45-degree field of view.
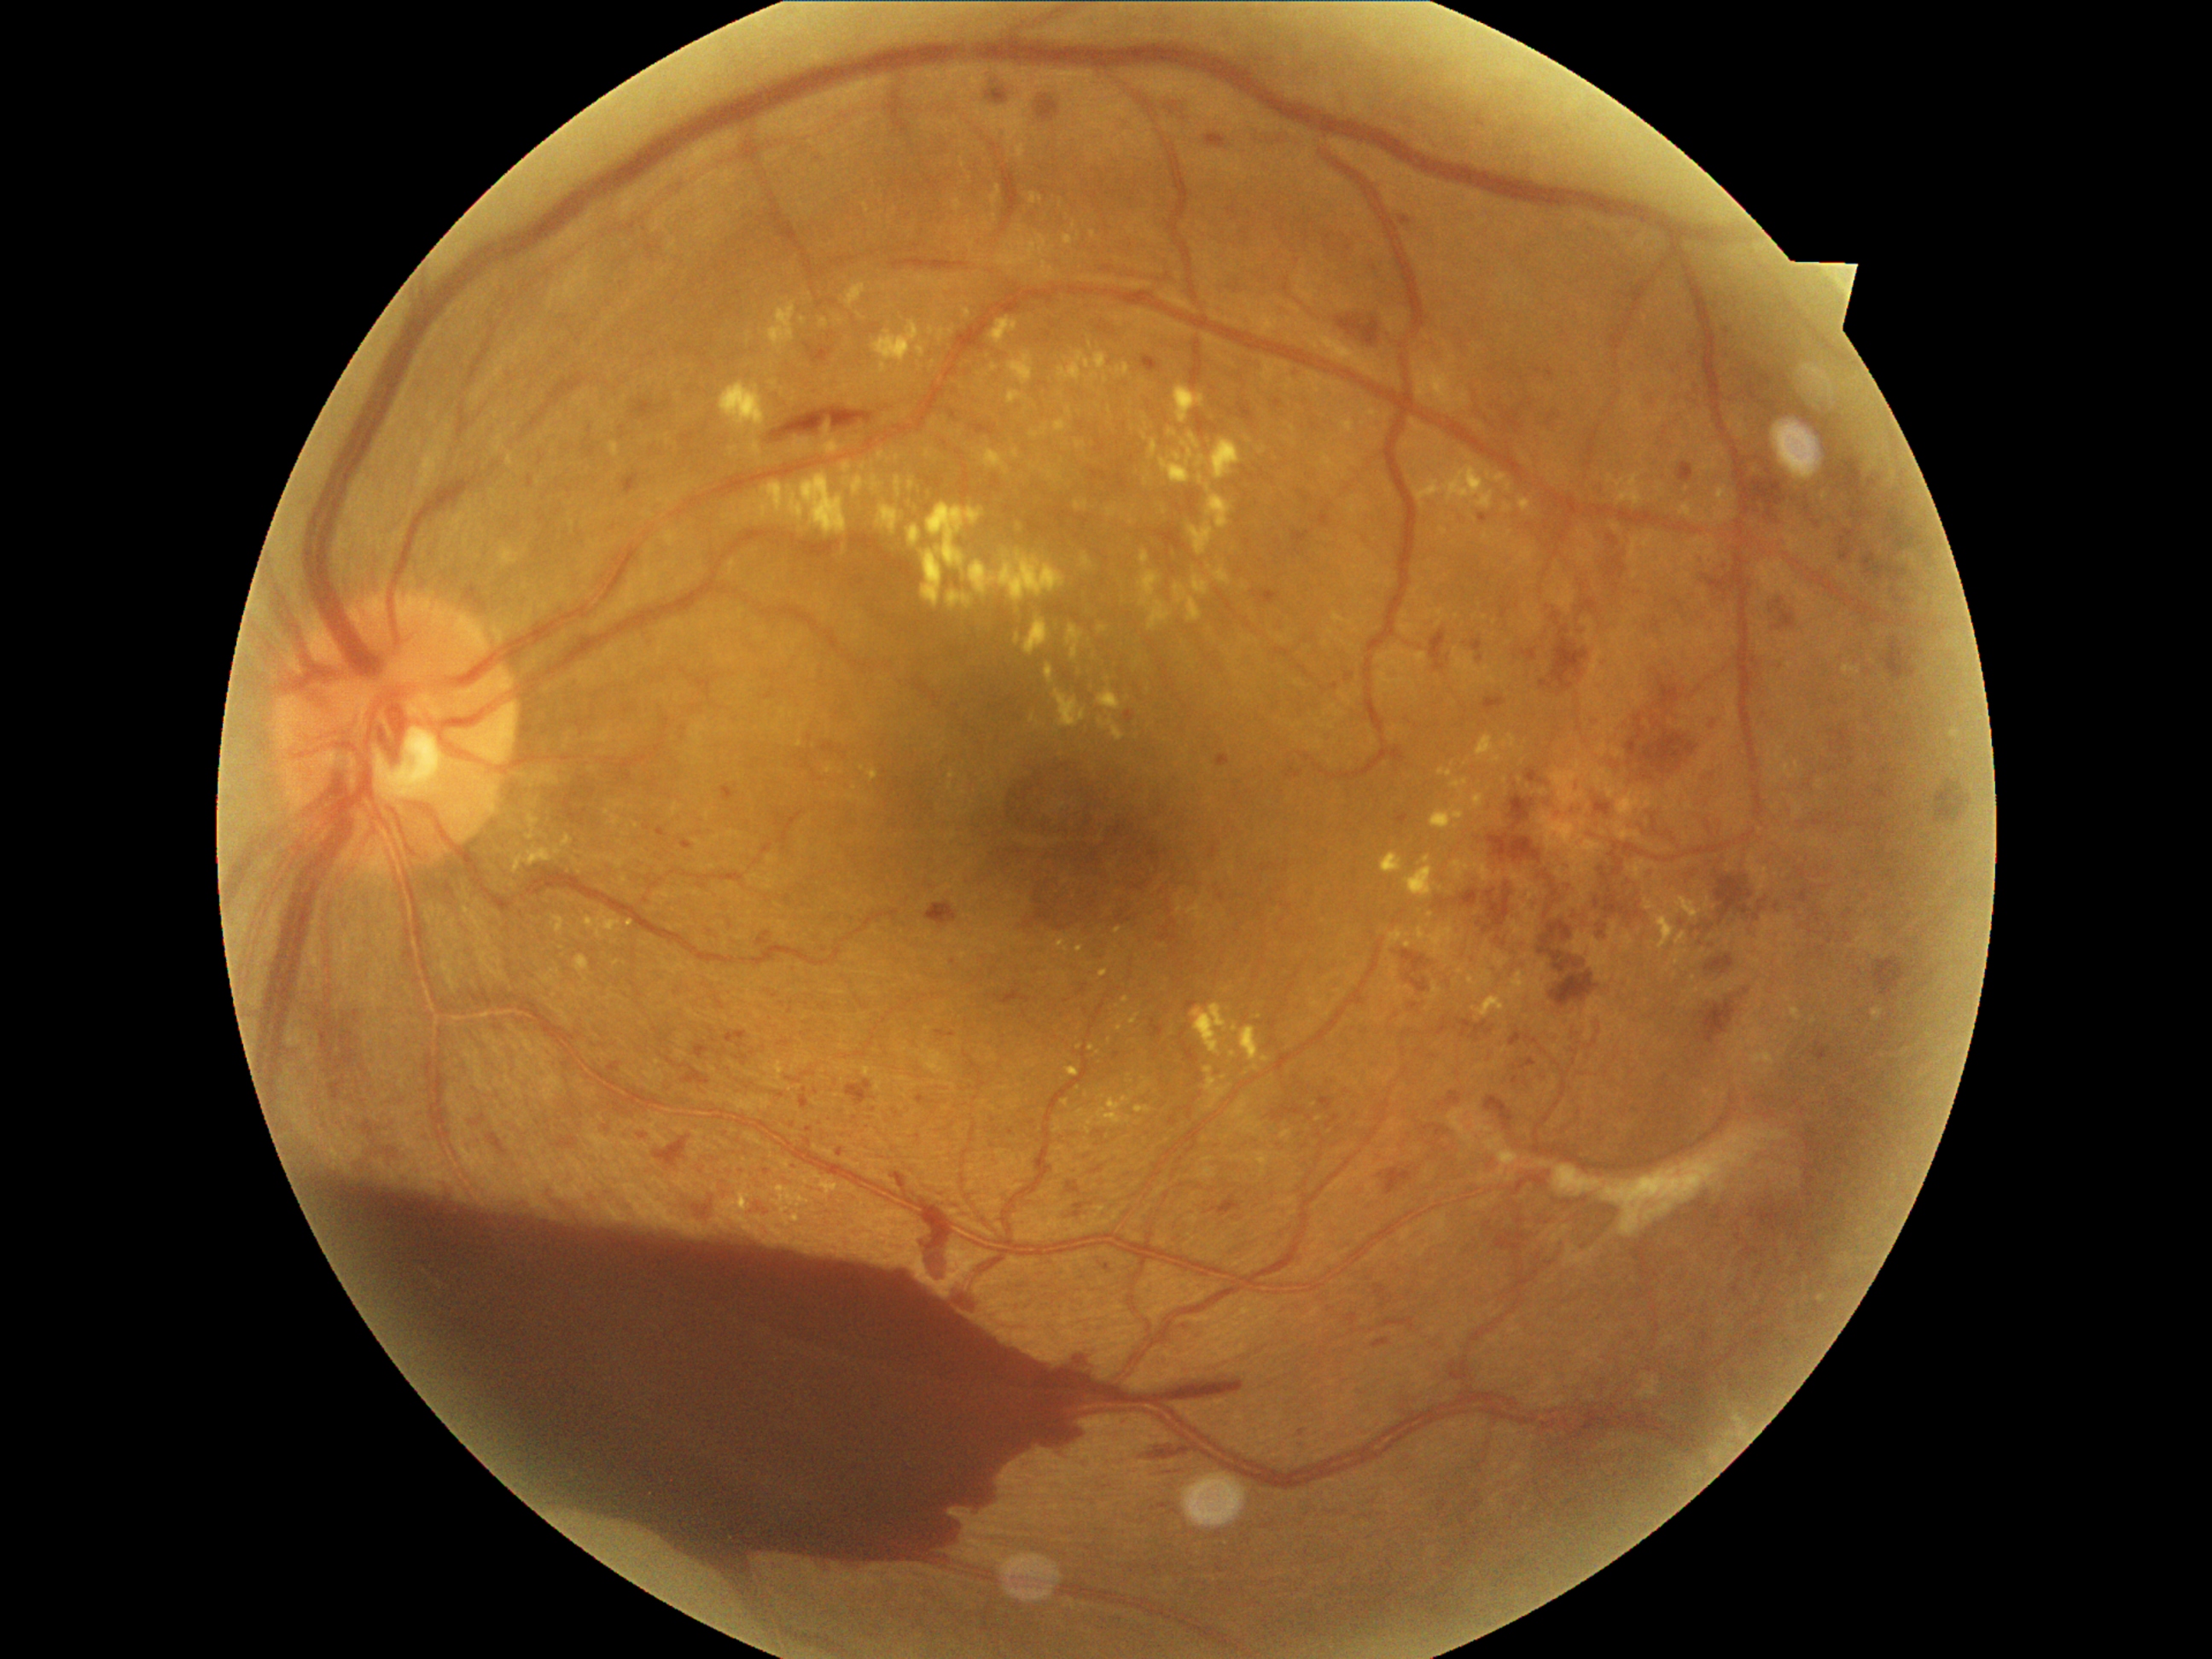
Diabetic retinopathy is grade 4 (PDR); proliferative diabetic retinopathy
A subset of detected lesions:
hard exudates (more not shown): left=1066, top=1068, right=1080, bottom=1076, left=916, top=342, right=926, bottom=359, left=1139, top=573, right=1172, bottom=631, left=1100, top=970, right=1110, bottom=977, left=1081, top=277, right=1114, bottom=284, left=1173, top=585, right=1204, bottom=622, left=989, top=318, right=1018, bottom=346, left=909, top=479, right=916, bottom=492, left=1074, top=501, right=1088, bottom=511, left=1008, top=390, right=1030, bottom=405, left=1056, top=1121, right=1062, bottom=1132, left=1098, top=690, right=1122, bottom=711, left=921, top=504, right=984, bottom=608
Small hard exudates near point(1033, 719), point(630, 924), point(1227, 989), point(958, 233), point(1461, 970), point(1106, 380)
hemorrhages (more not shown): left=1588, top=851, right=1646, bottom=923, left=1039, top=98, right=1059, bottom=120, left=1626, top=716, right=1701, bottom=767, left=1496, top=1228, right=1528, bottom=1252, left=1701, top=998, right=1737, bottom=1045, left=987, top=90, right=1006, bottom=103, left=1144, top=1441, right=1187, bottom=1464, left=1486, top=882, right=1513, bottom=928, left=748, top=1202, right=772, bottom=1216, left=919, top=1223, right=952, bottom=1286, left=890, top=259, right=969, bottom=272, left=926, top=902, right=958, bottom=929, left=1706, top=955, right=1735, bottom=975, left=1487, top=835, right=1542, bottom=863, left=1552, top=626, right=1590, bottom=690, left=1336, top=317, right=1382, bottom=347, left=1551, top=970, right=1598, bottom=1010
Small hemorrhages near point(1915, 646), point(1922, 653)
microaneurysms (more not shown): left=1400, top=216, right=1412, bottom=226, left=1634, top=230, right=1648, bottom=245, left=682, top=842, right=694, bottom=851, left=1429, top=631, right=1445, bottom=672, left=1076, top=1358, right=1085, bottom=1366, left=1578, top=626, right=1592, bottom=637, left=1238, top=404, right=1255, bottom=426, left=1151, top=1020, right=1165, bottom=1039, left=1571, top=779, right=1578, bottom=793, left=1406, top=974, right=1429, bottom=992, left=1143, top=356, right=1160, bottom=373, left=1513, top=1076, right=1518, bottom=1085, left=608, top=1062, right=622, bottom=1073, left=1486, top=1097, right=1515, bottom=1131, left=1549, top=366, right=1554, bottom=378
Small microaneurysms near point(1616, 587), point(1887, 538), point(1779, 602), point(710, 934), point(1199, 1076)